45° field of view · color fundus image — 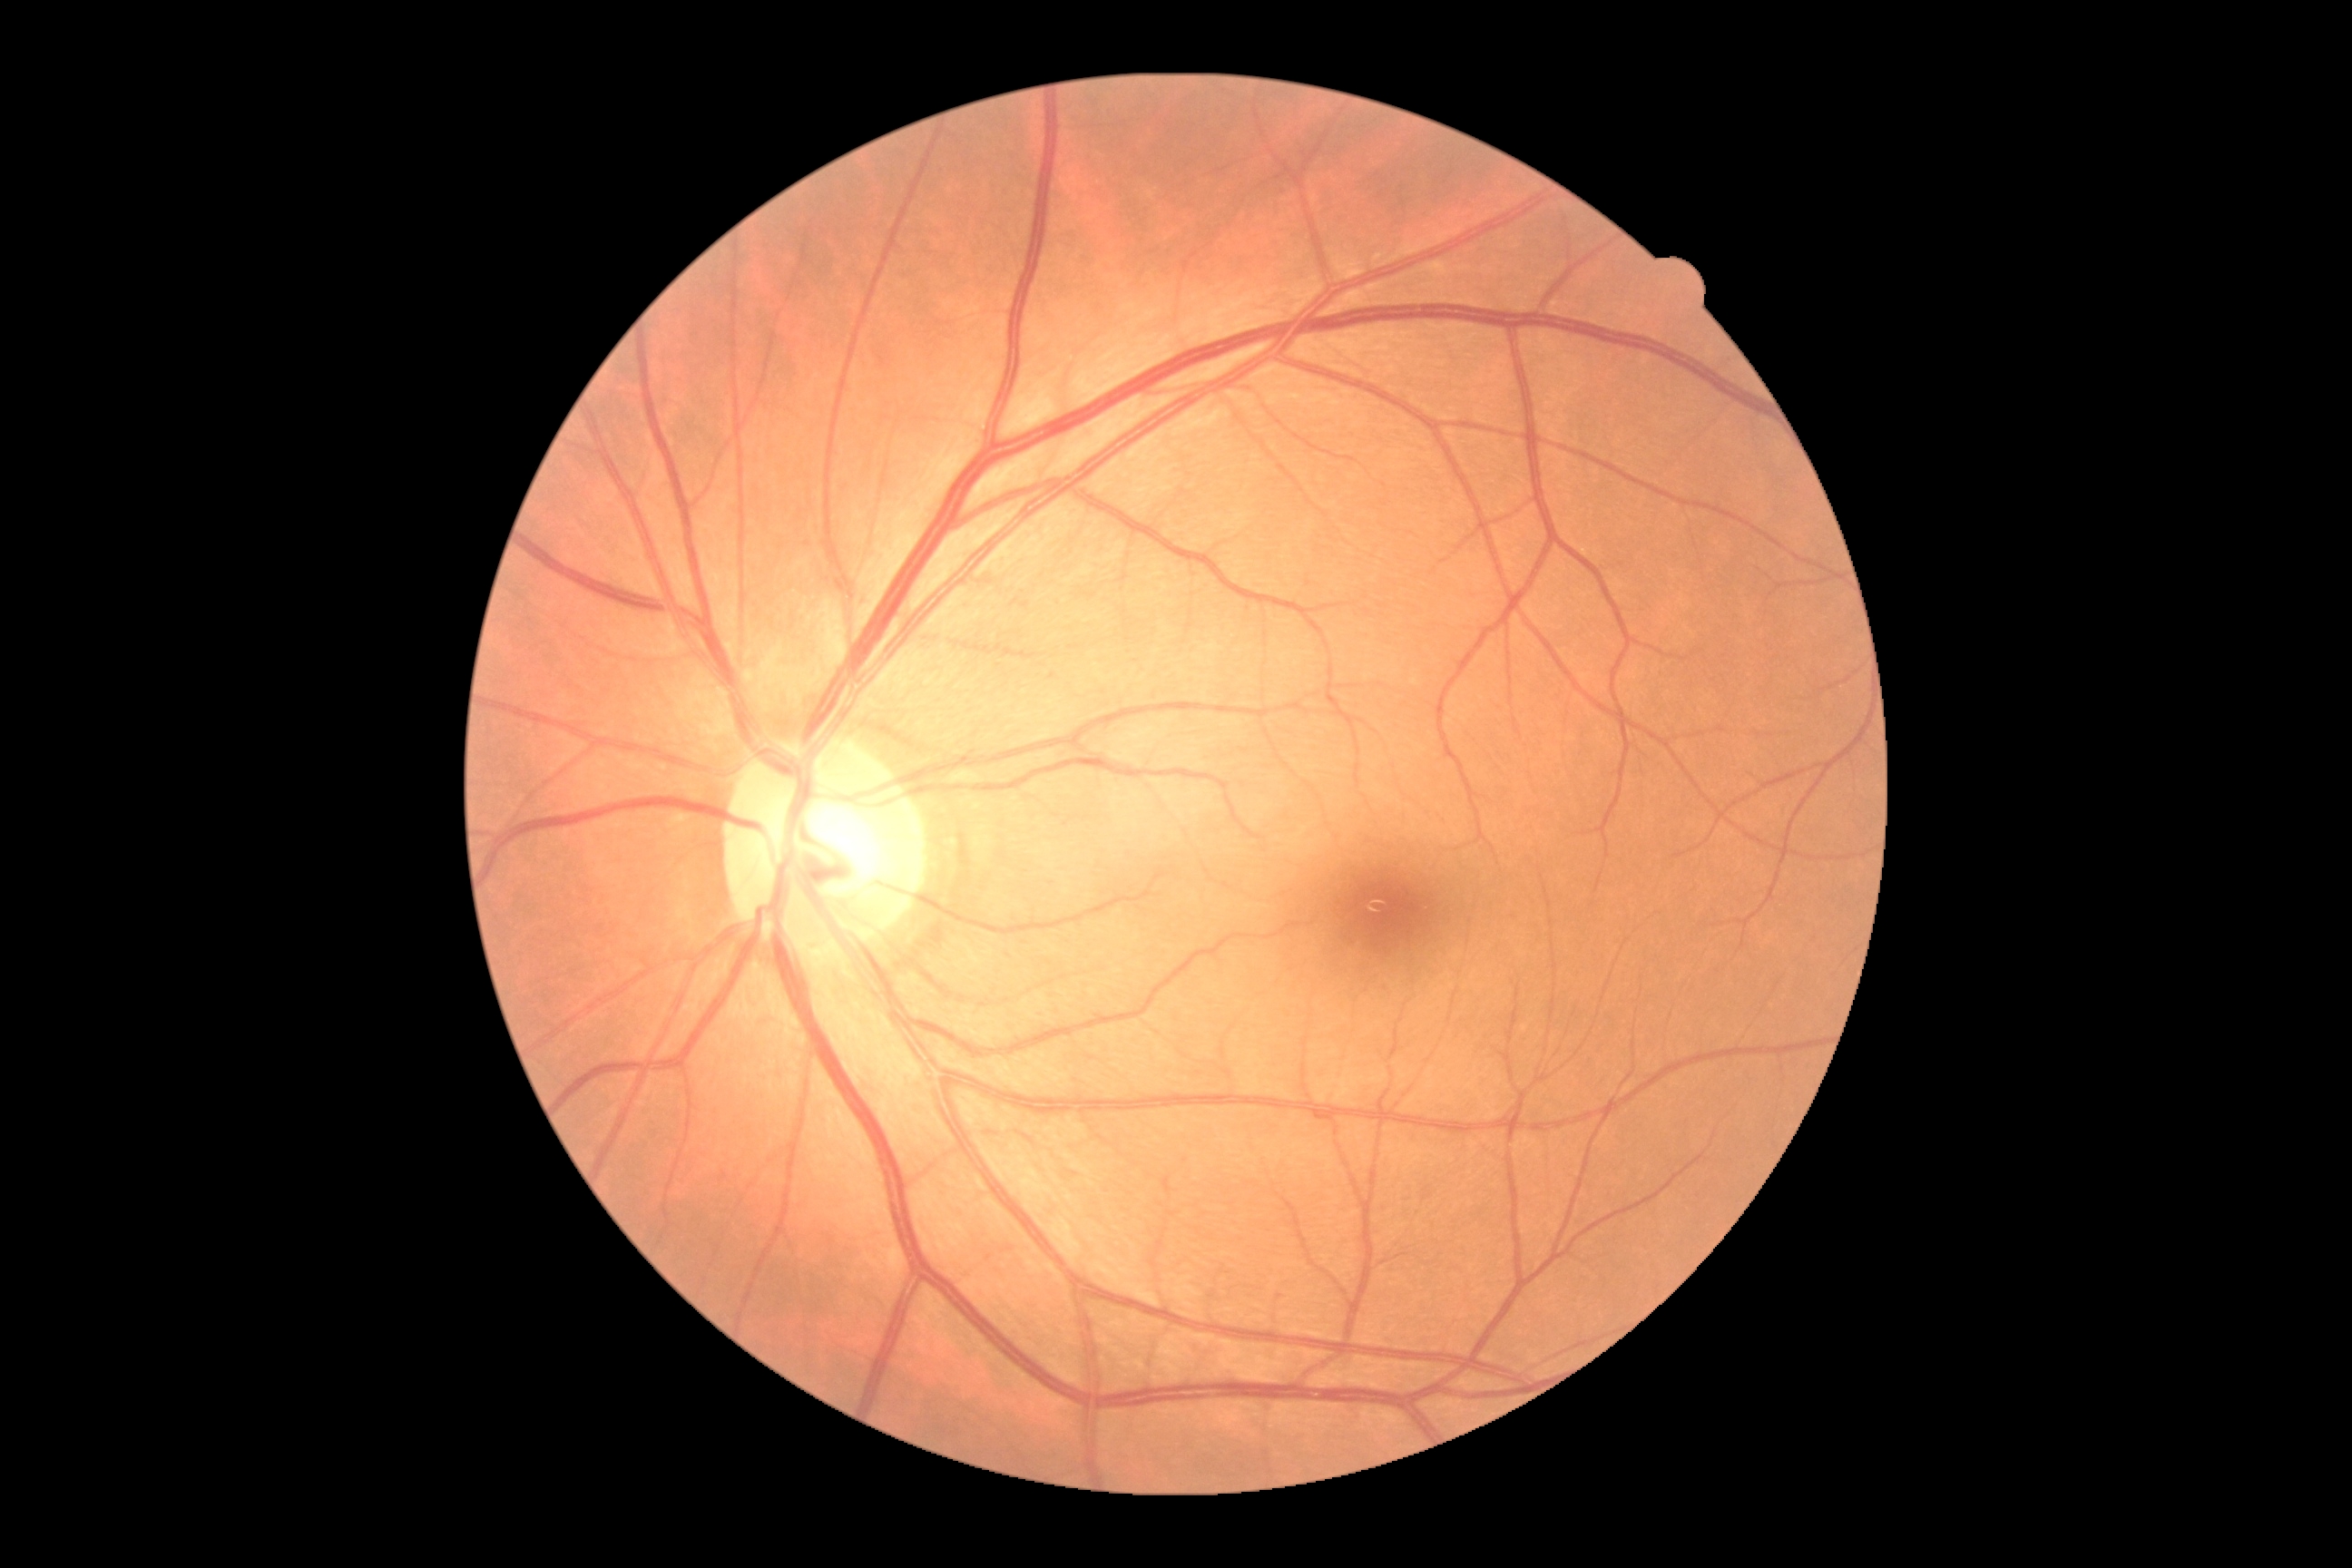 No signs of diabetic retinopathy. Diabetic retinopathy grade is 0 — no visible signs of diabetic retinopathy.